Wide-field fundus image from infant ROP screening; captured with the Clarity RetCam 3 (130° field of view): 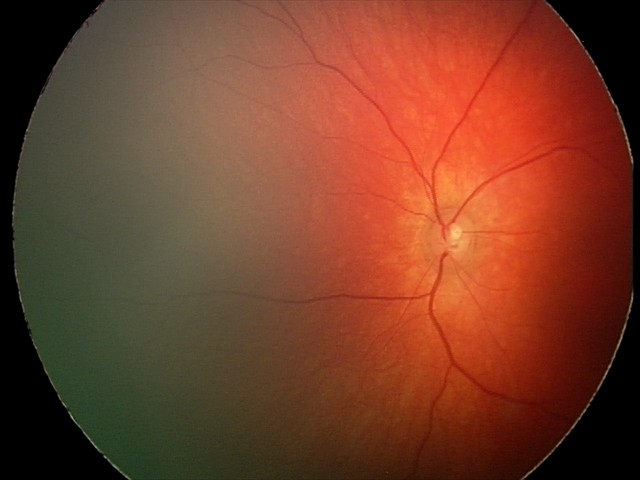

Screening examination consistent with retinal hemorrhages.